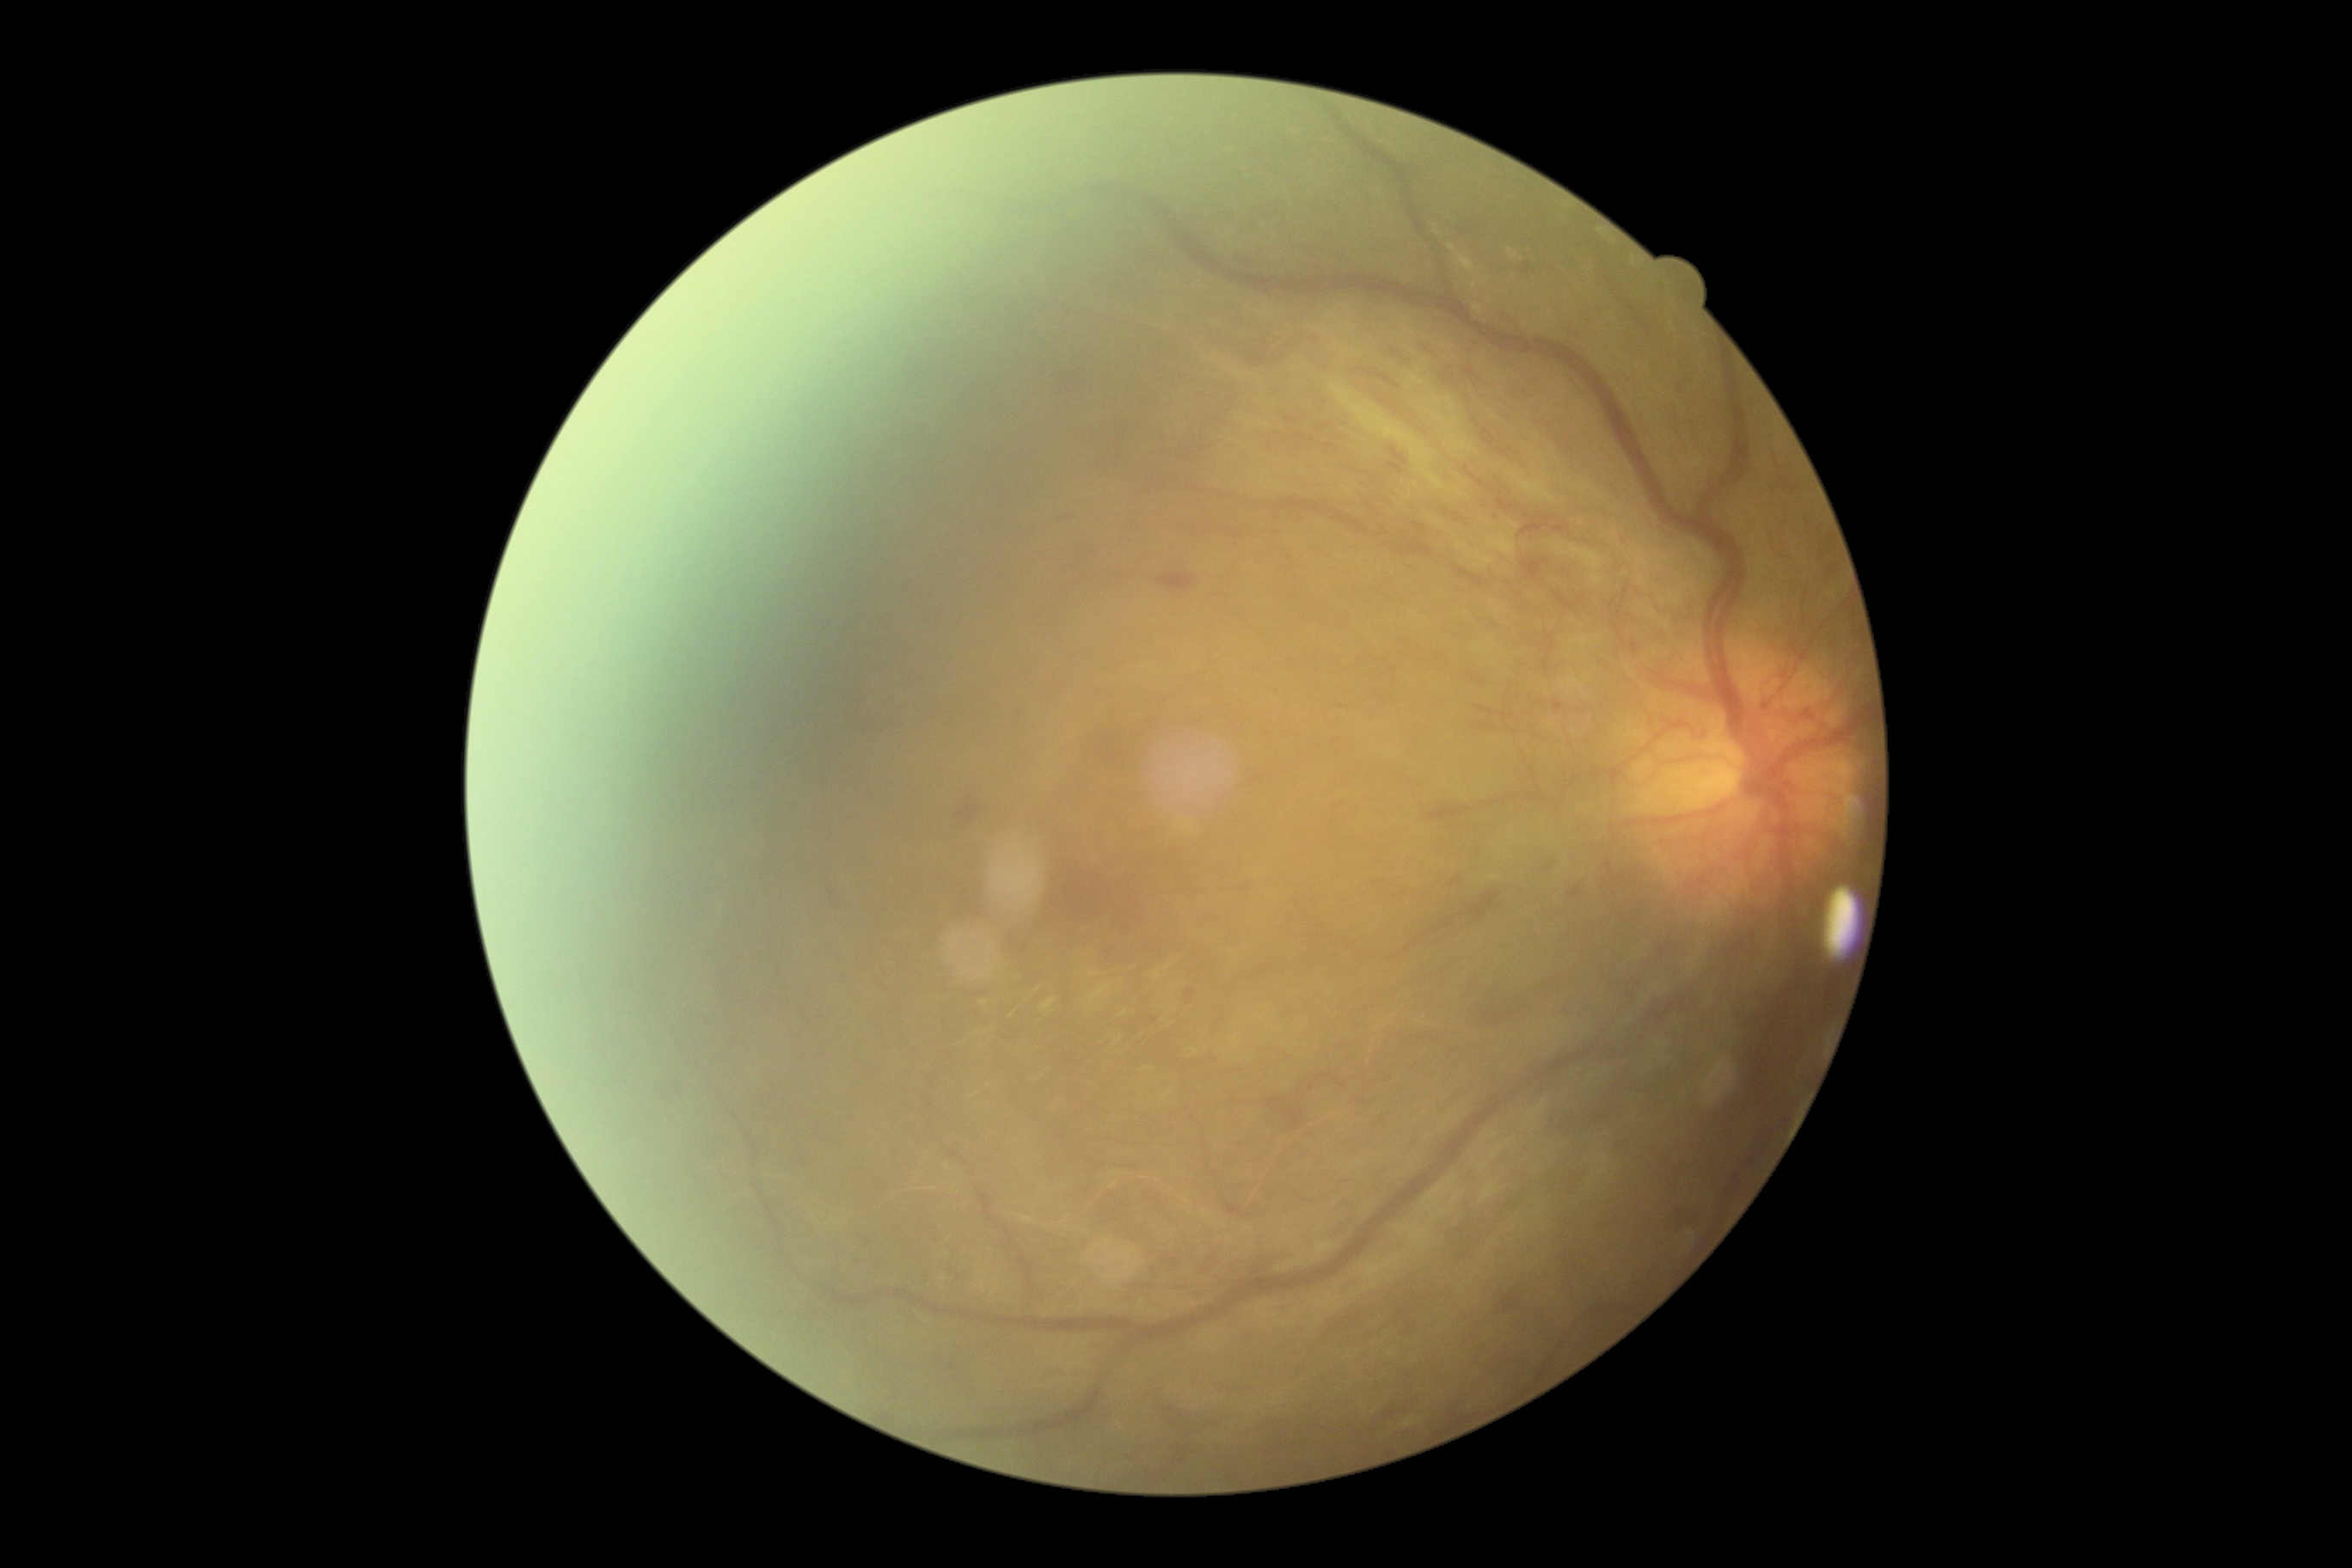
retinopathy grade: 4 (PDR).